Wide-field fundus photograph from neonatal ROP screening:
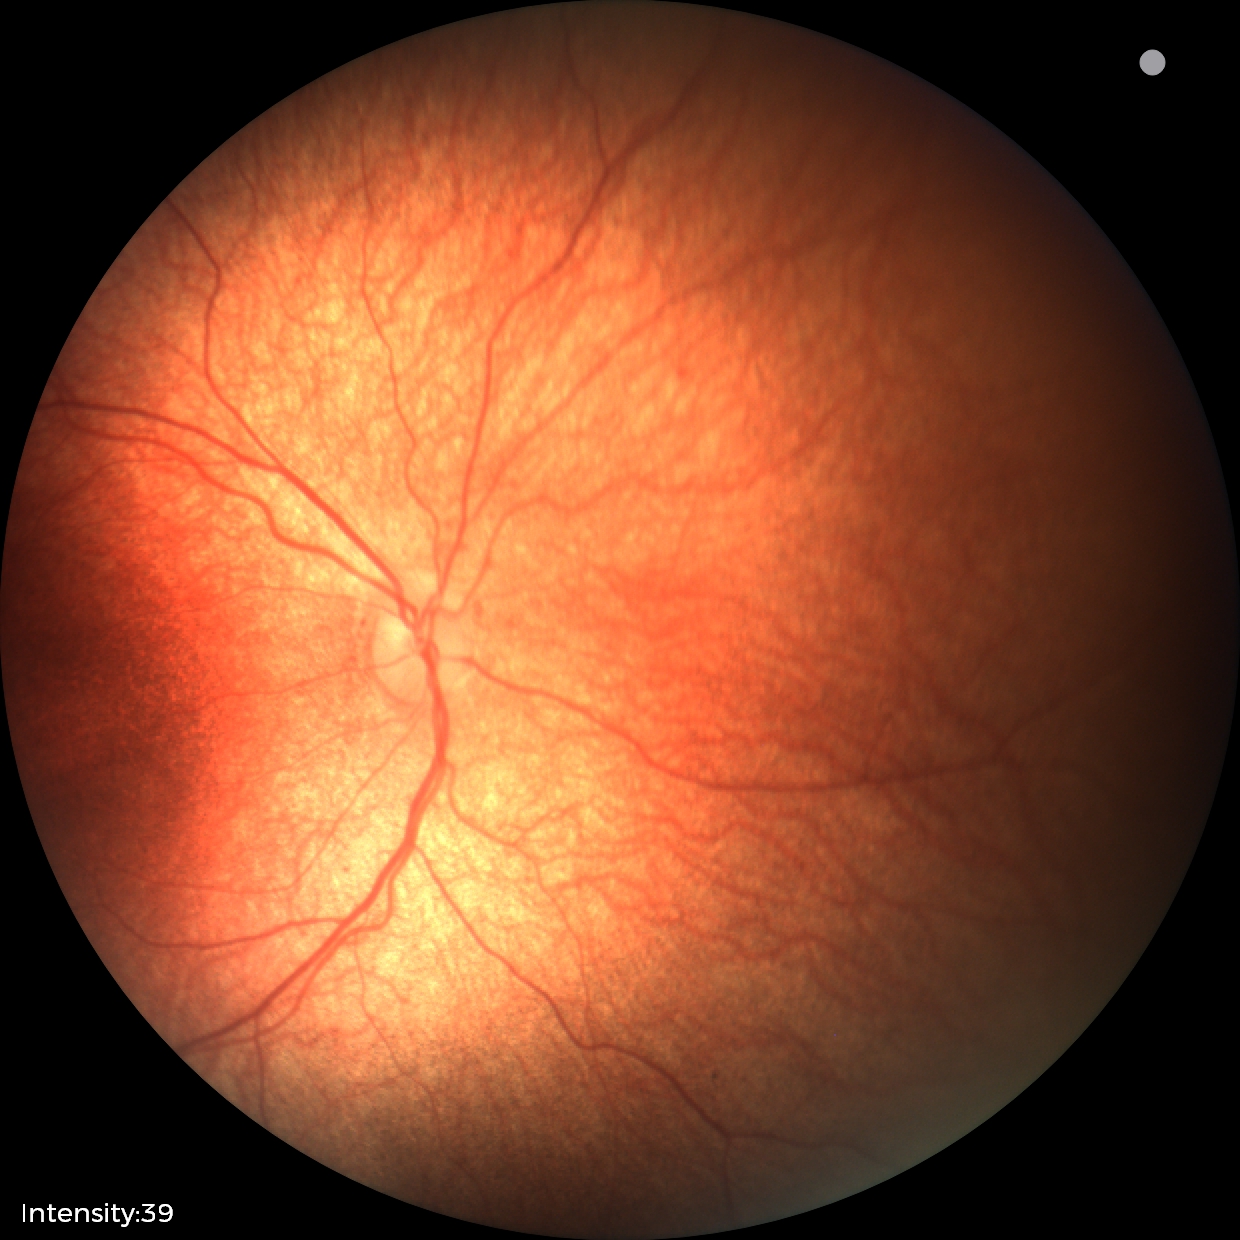 Impression: physiological appearance with no retinal pathology.